640x480 · RetCam wide-field infant fundus image: 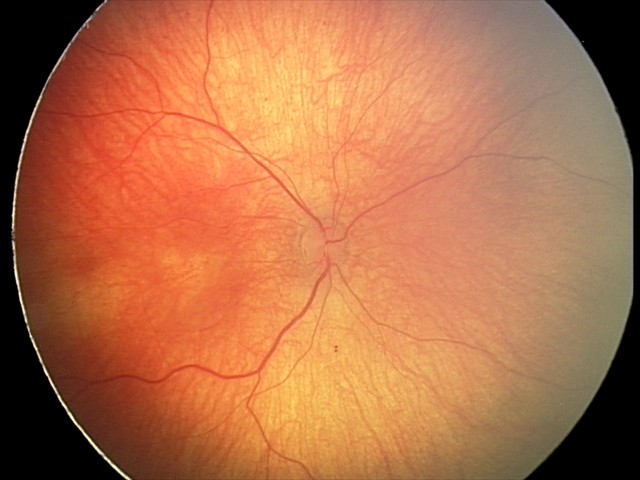
Screening examination diagnosed as physiological.